45° field of view · 2352 x 1568 pixels · color fundus image.
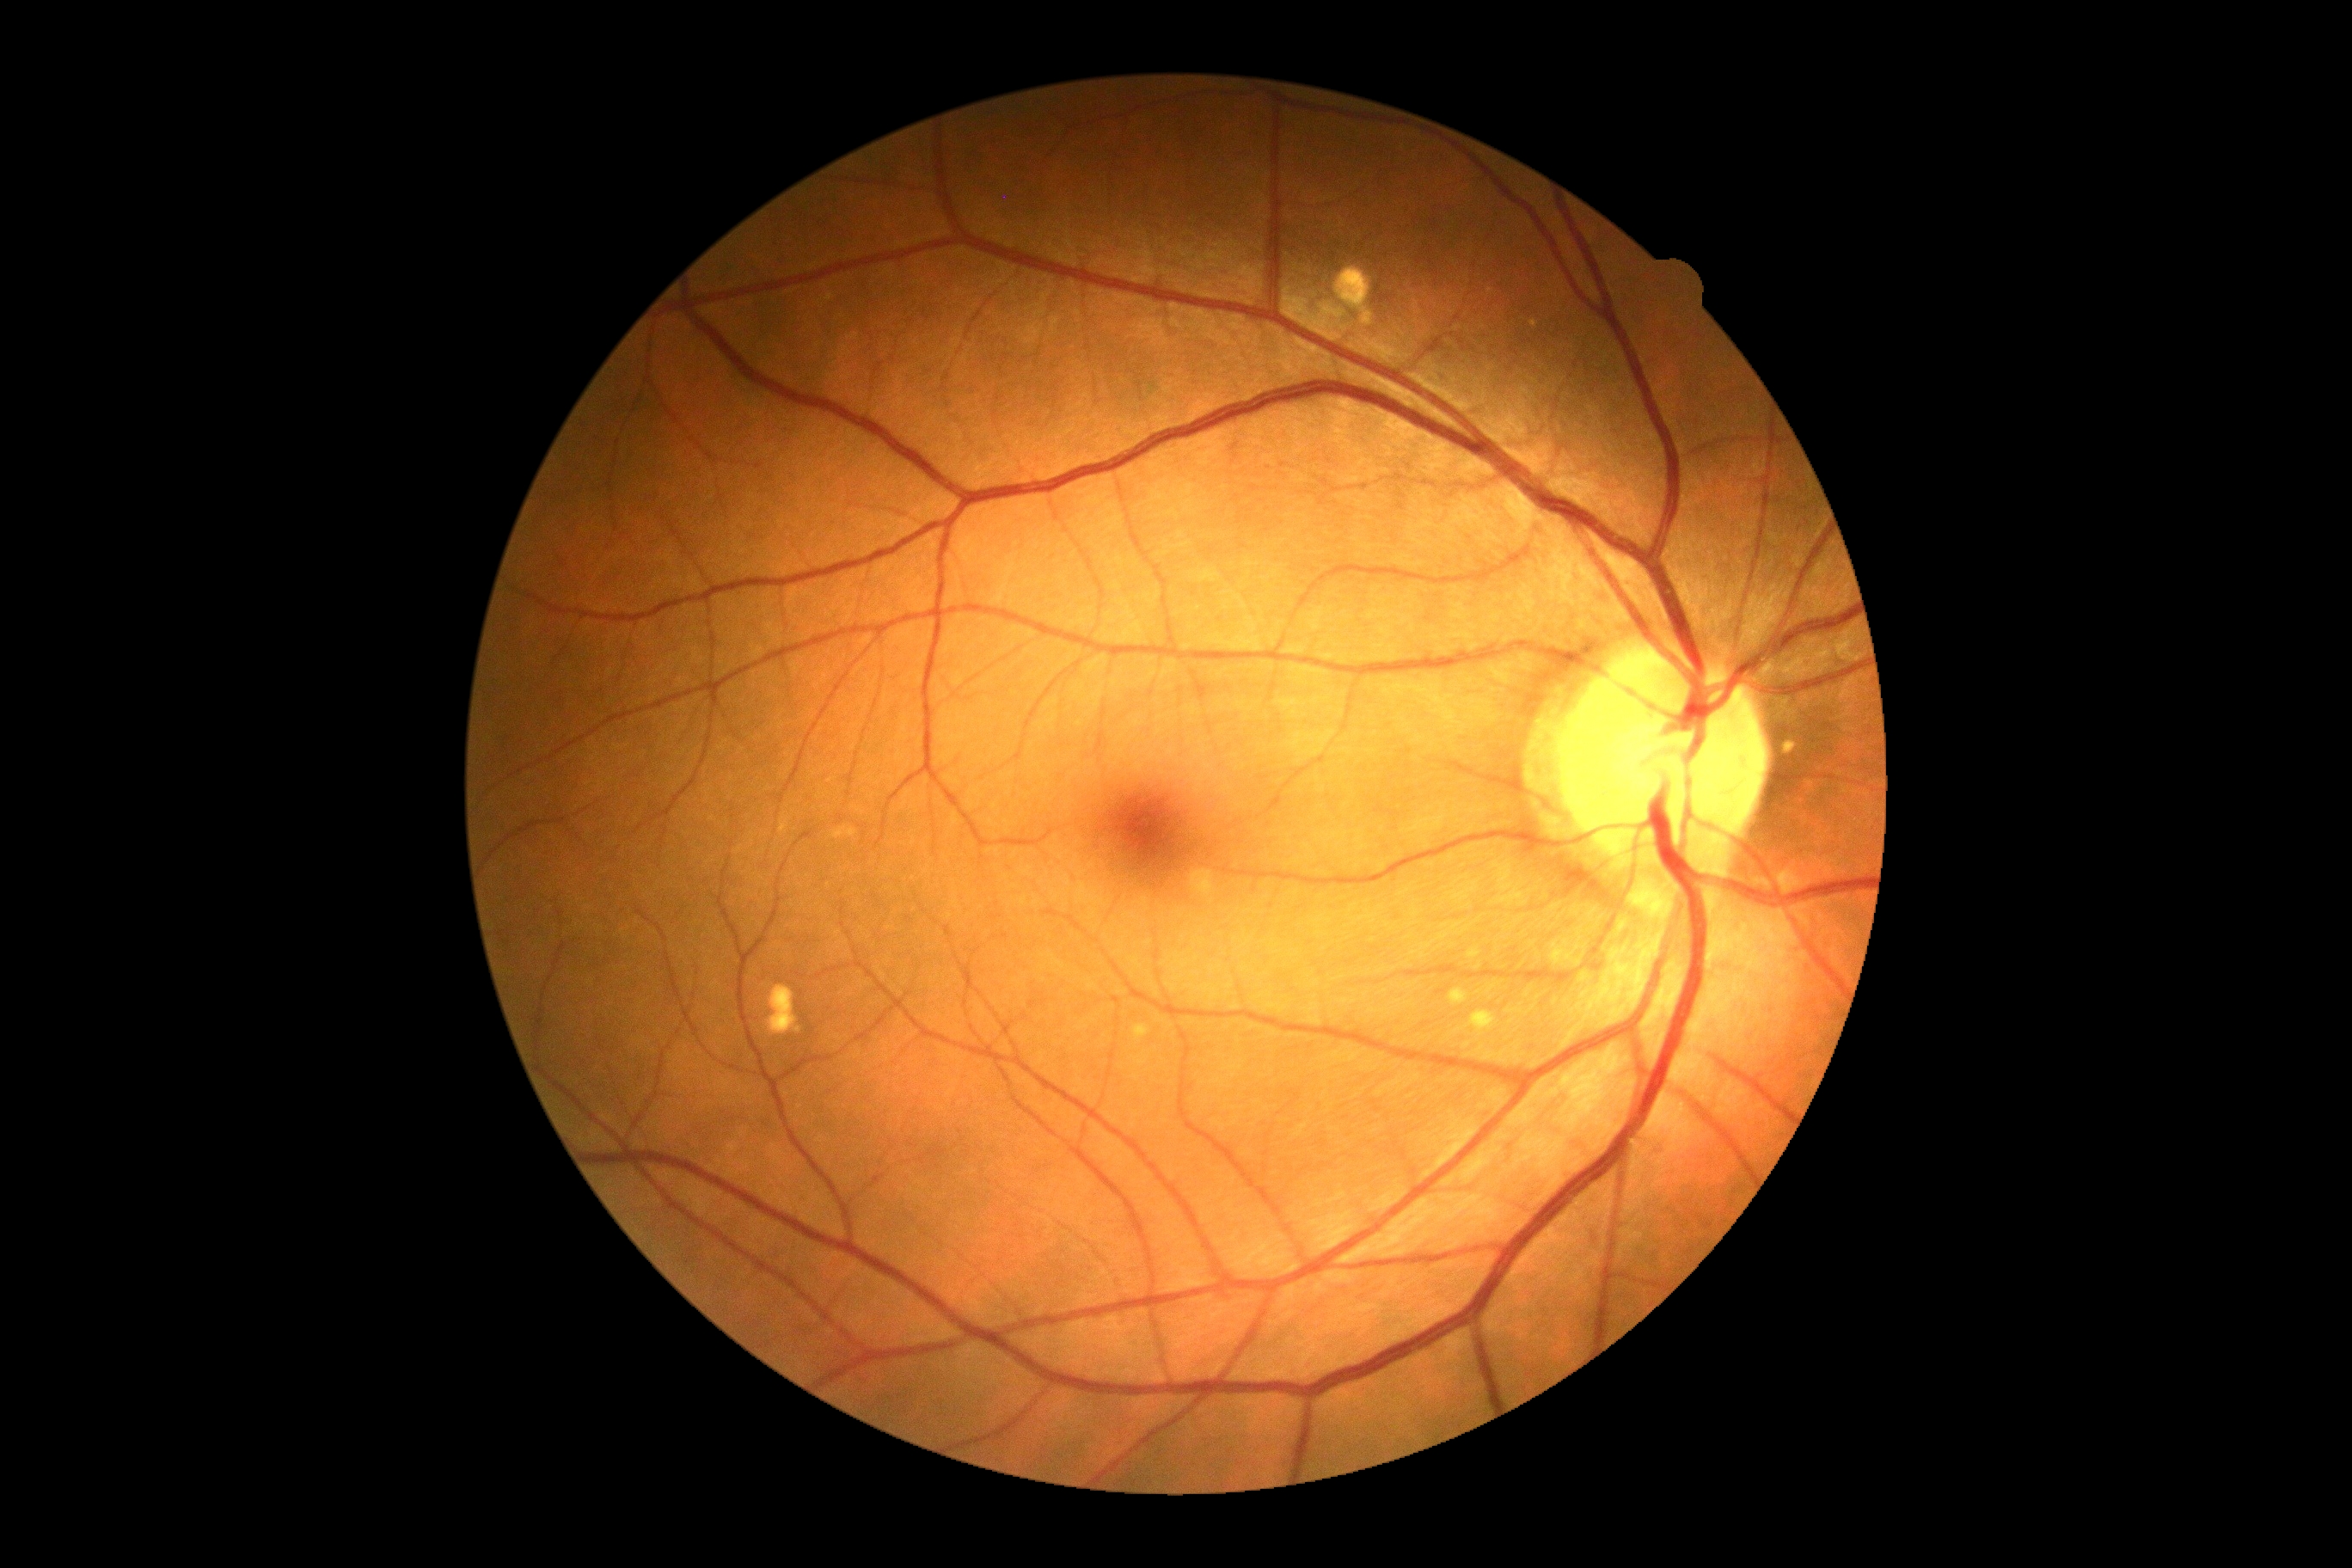
DR is grade 0 — no visible signs of diabetic retinopathy.